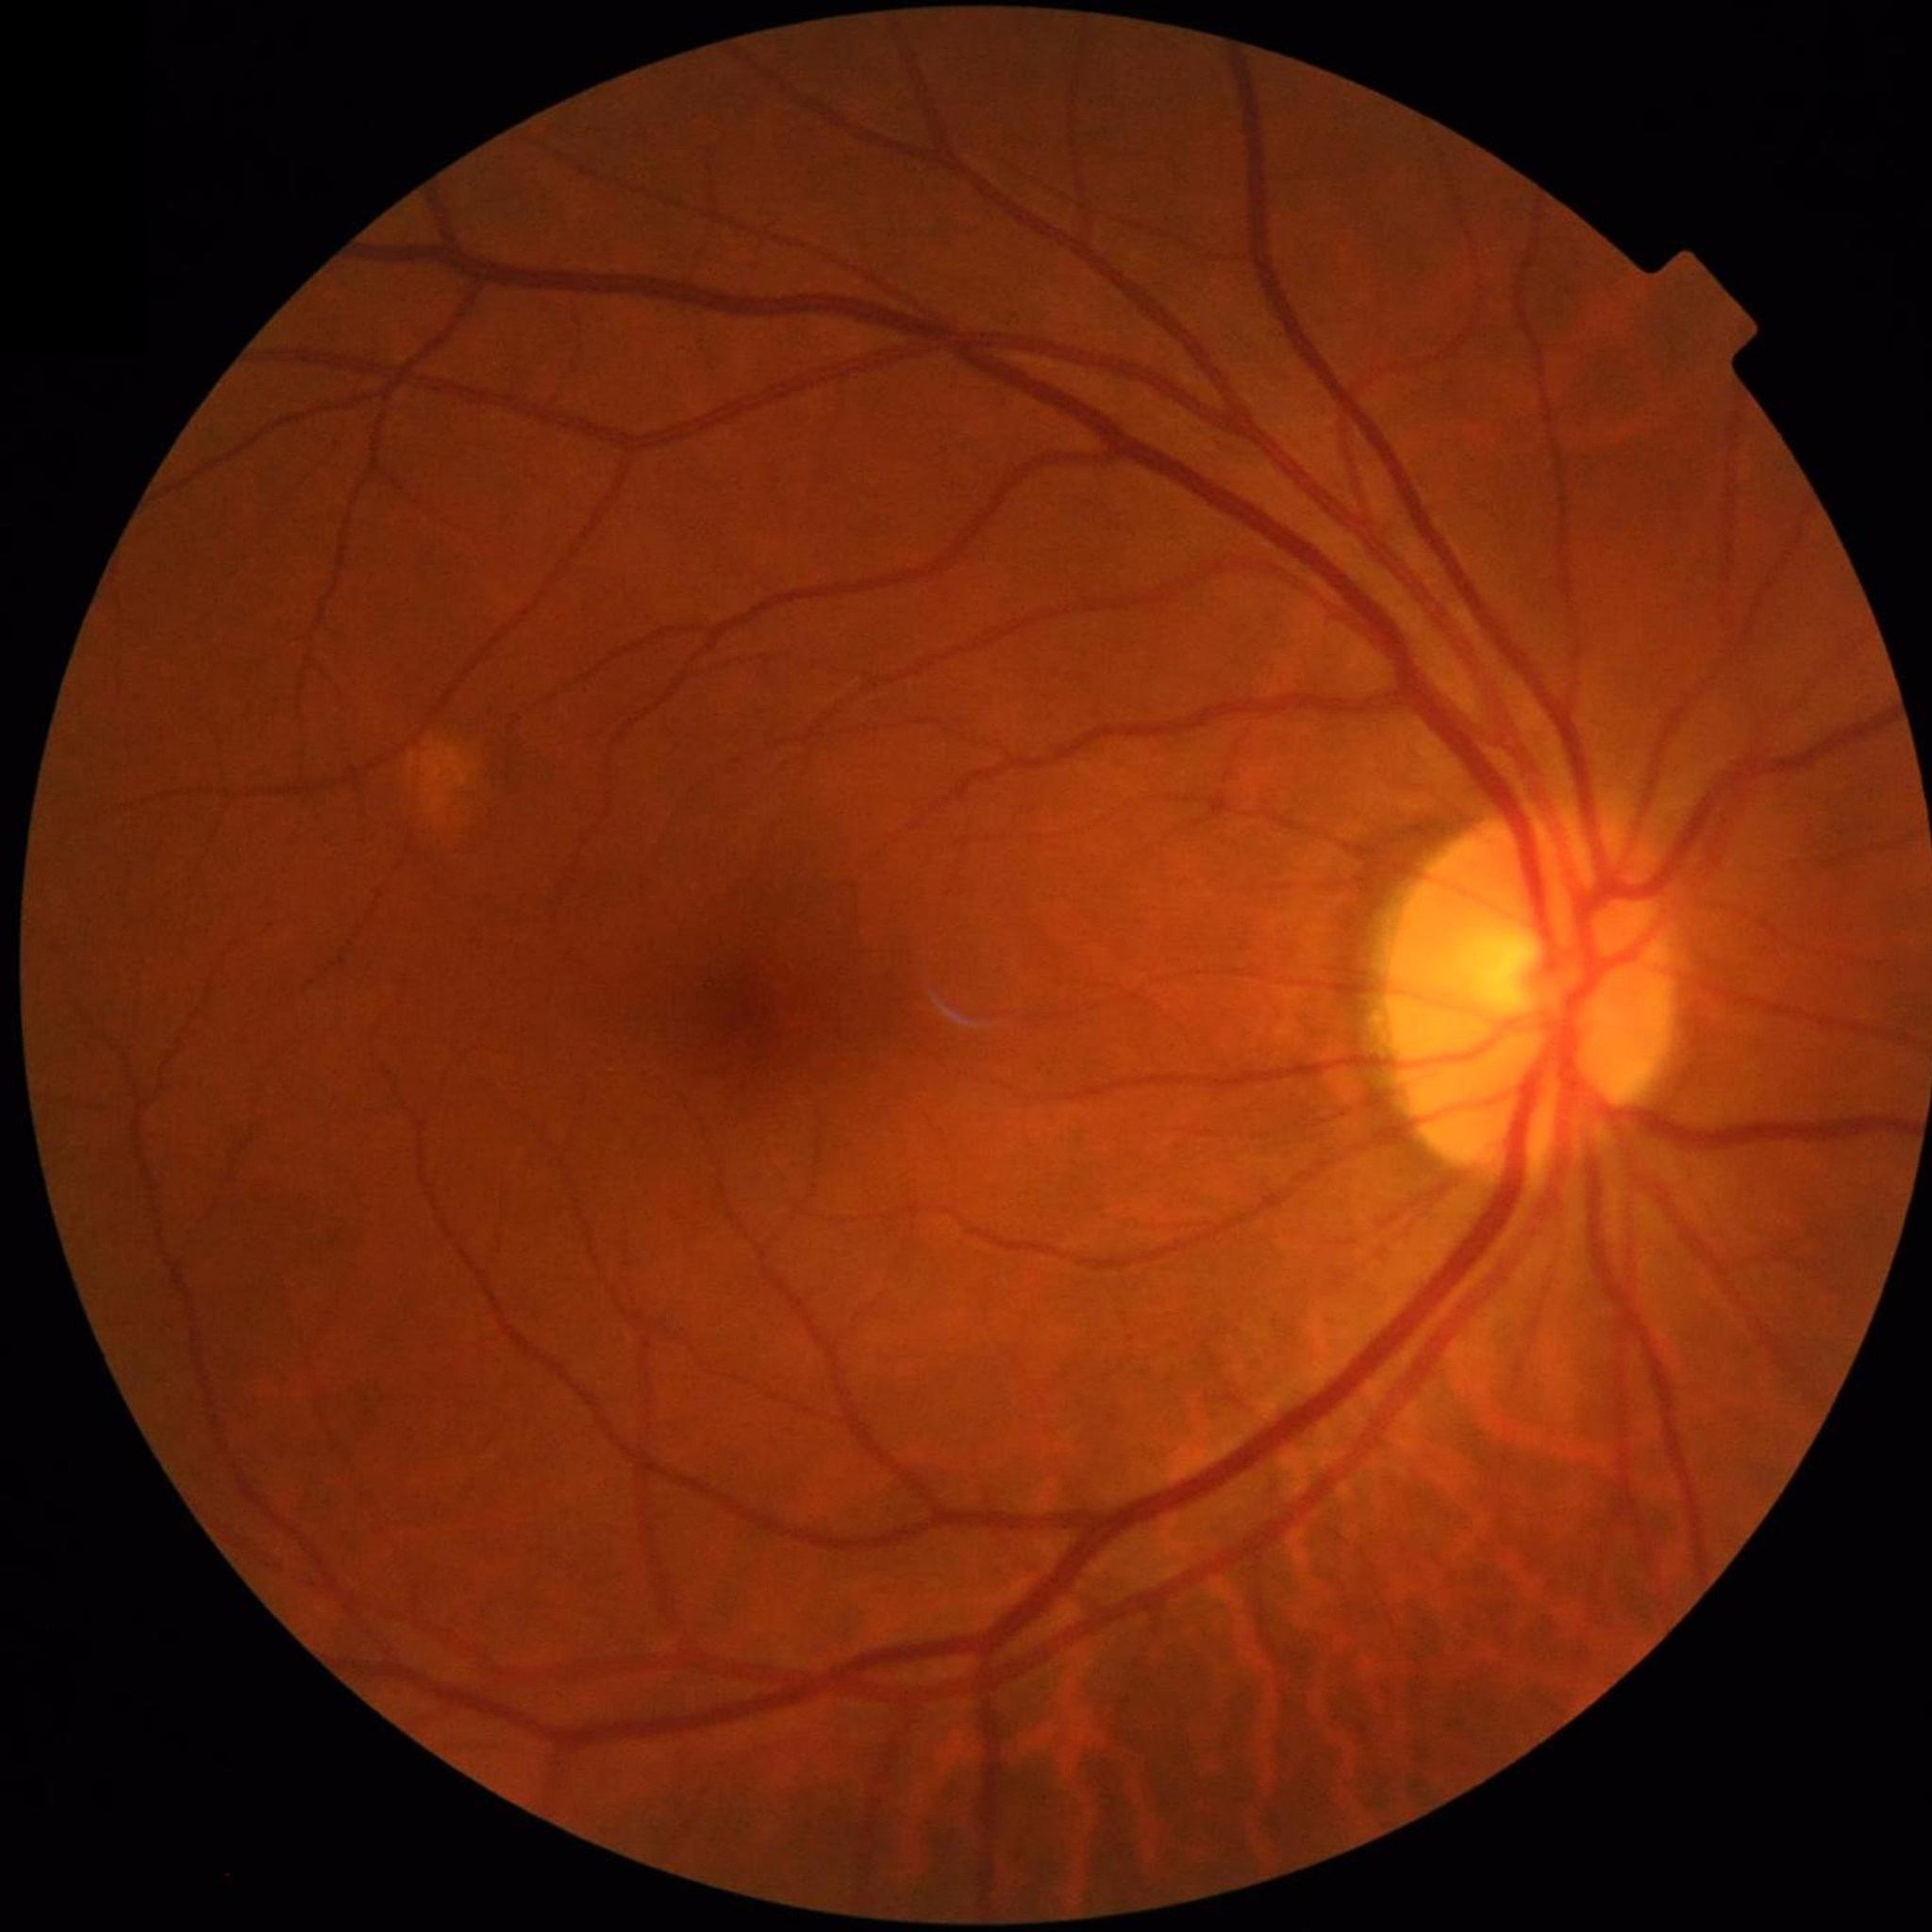
Condition: no AMD, DR, or glaucomatous findings | Quality assessment: contrast adequate, illumination and color satisfactory, no blur.